Optic disc photograph.
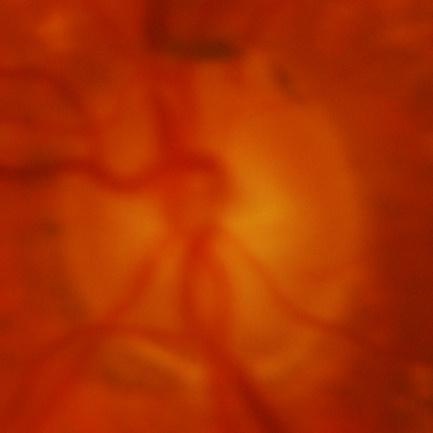 Glaucoma is present. Findings consistent with glaucoma.